Pupil-dilated: 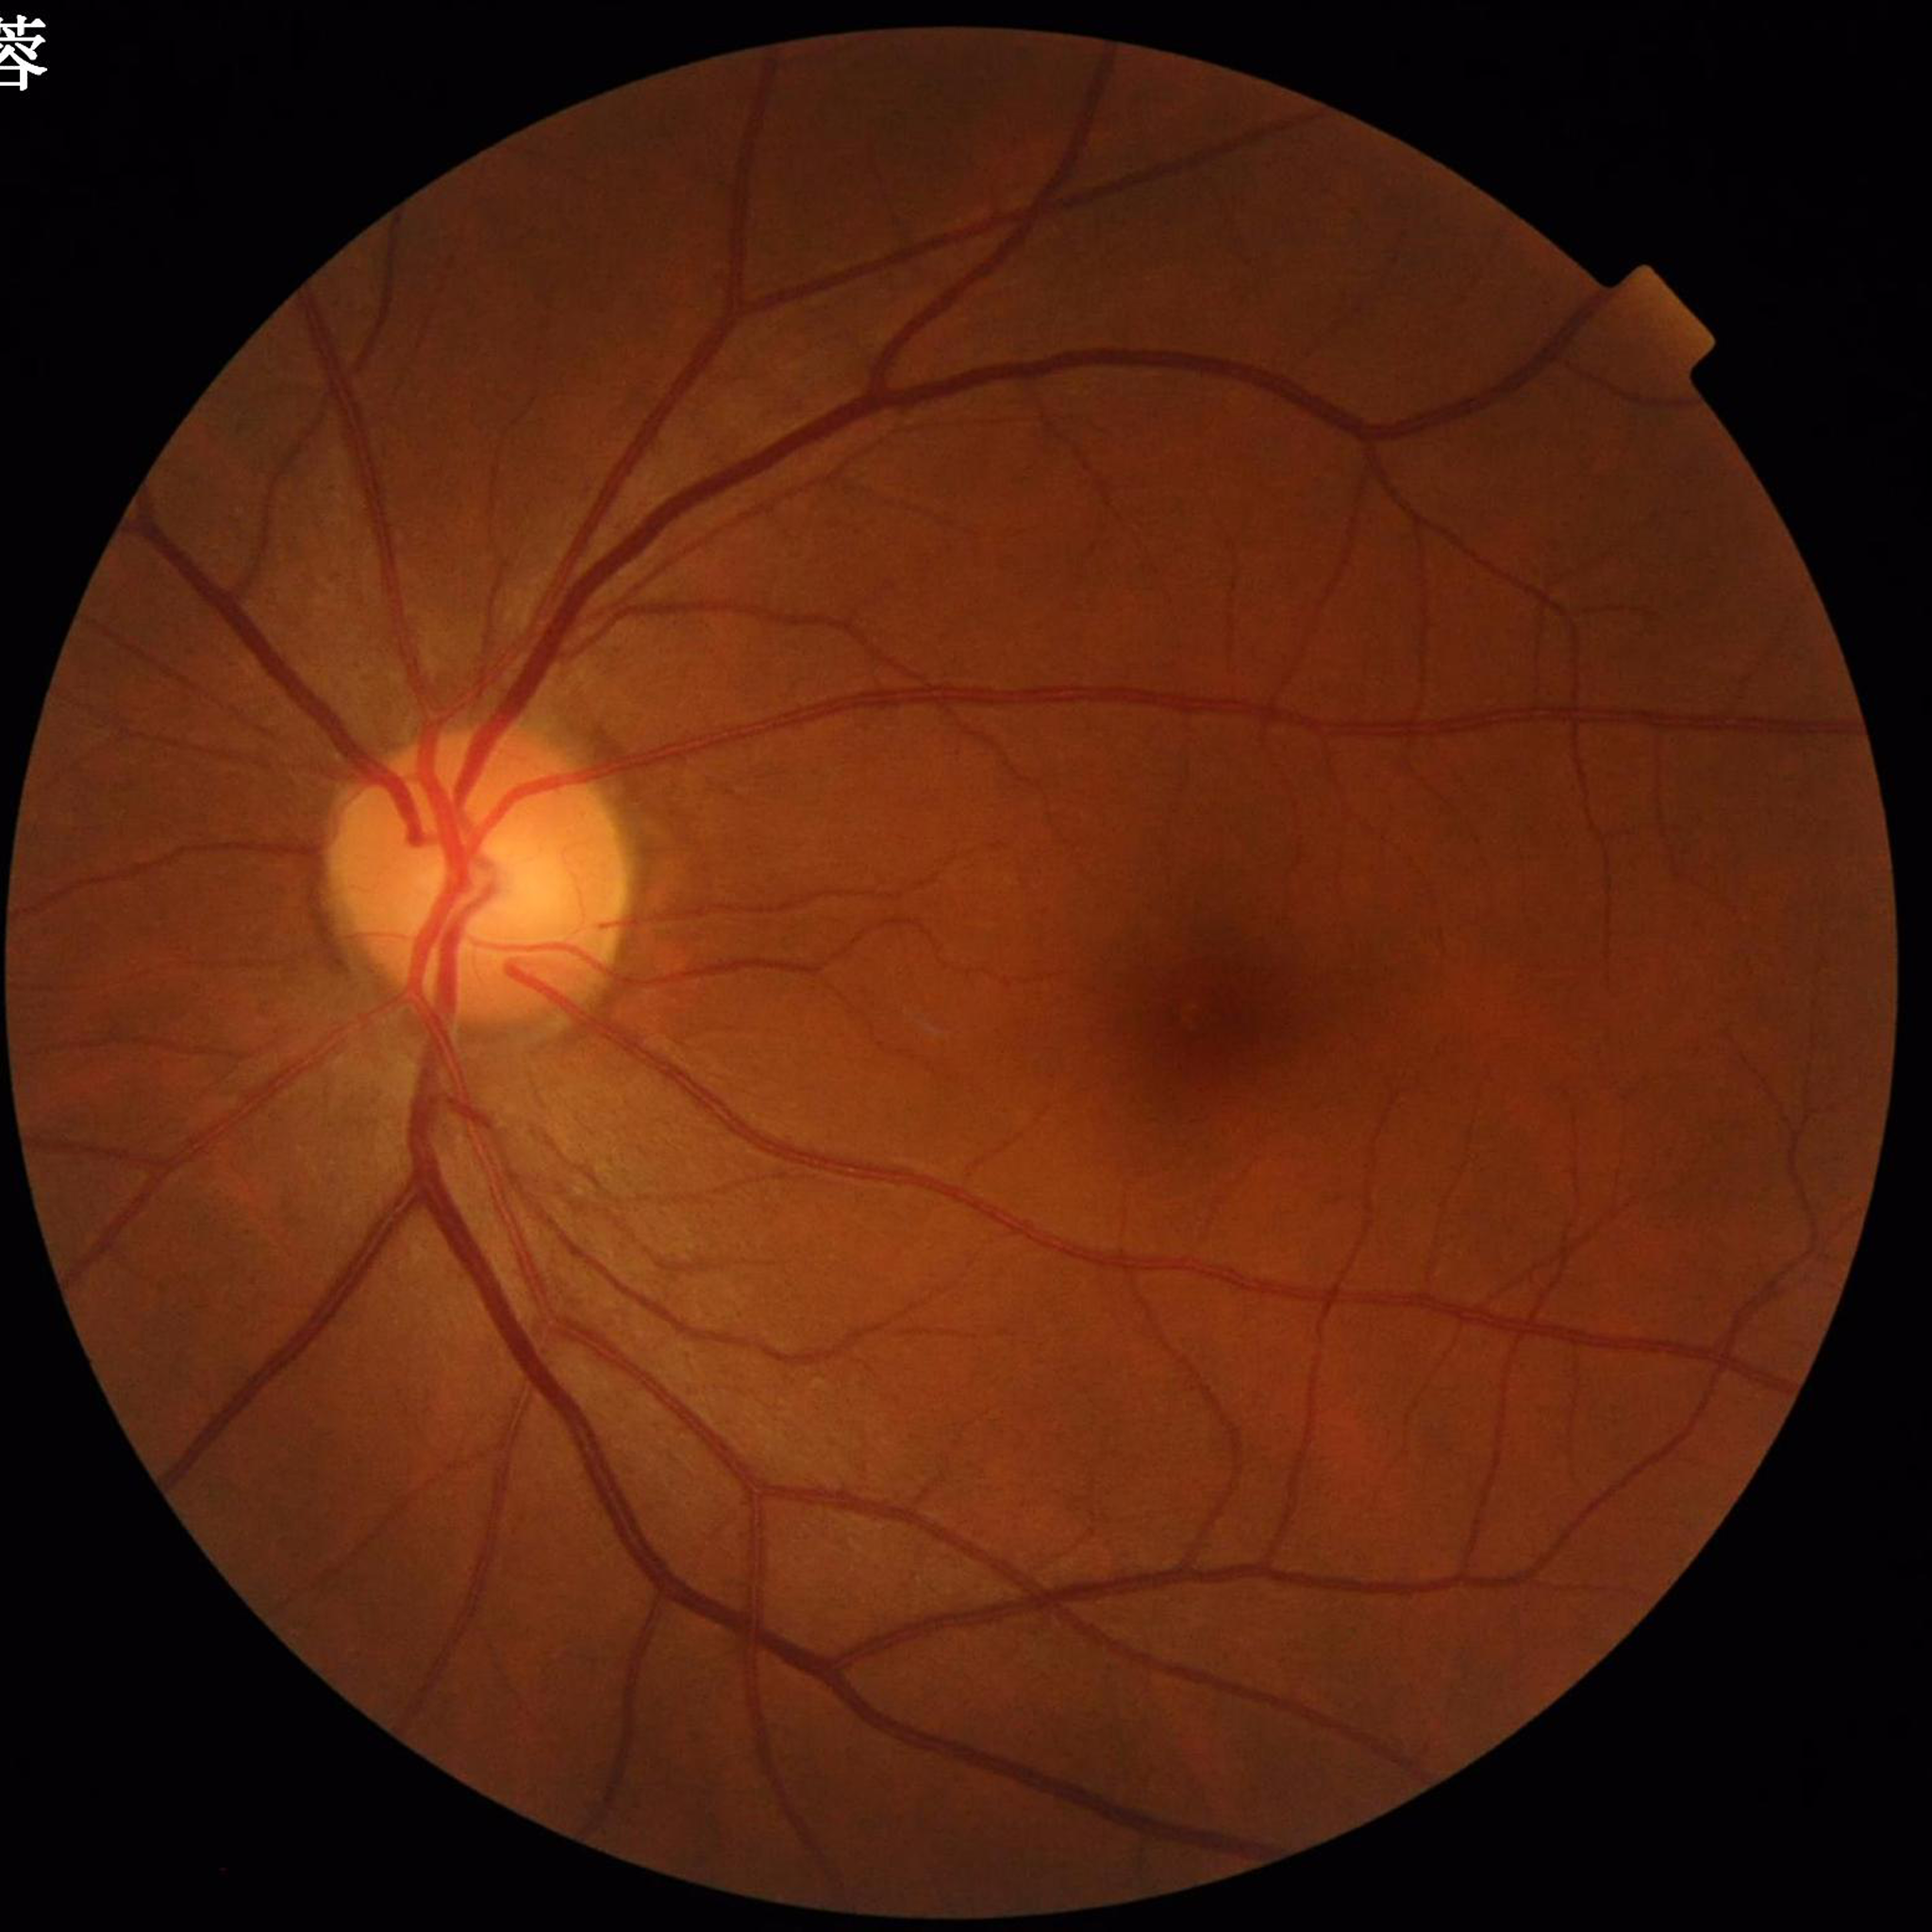 Fundus image of an eye with glaucoma.
Photo quality: satisfactory.